Infant wide-field retinal image.
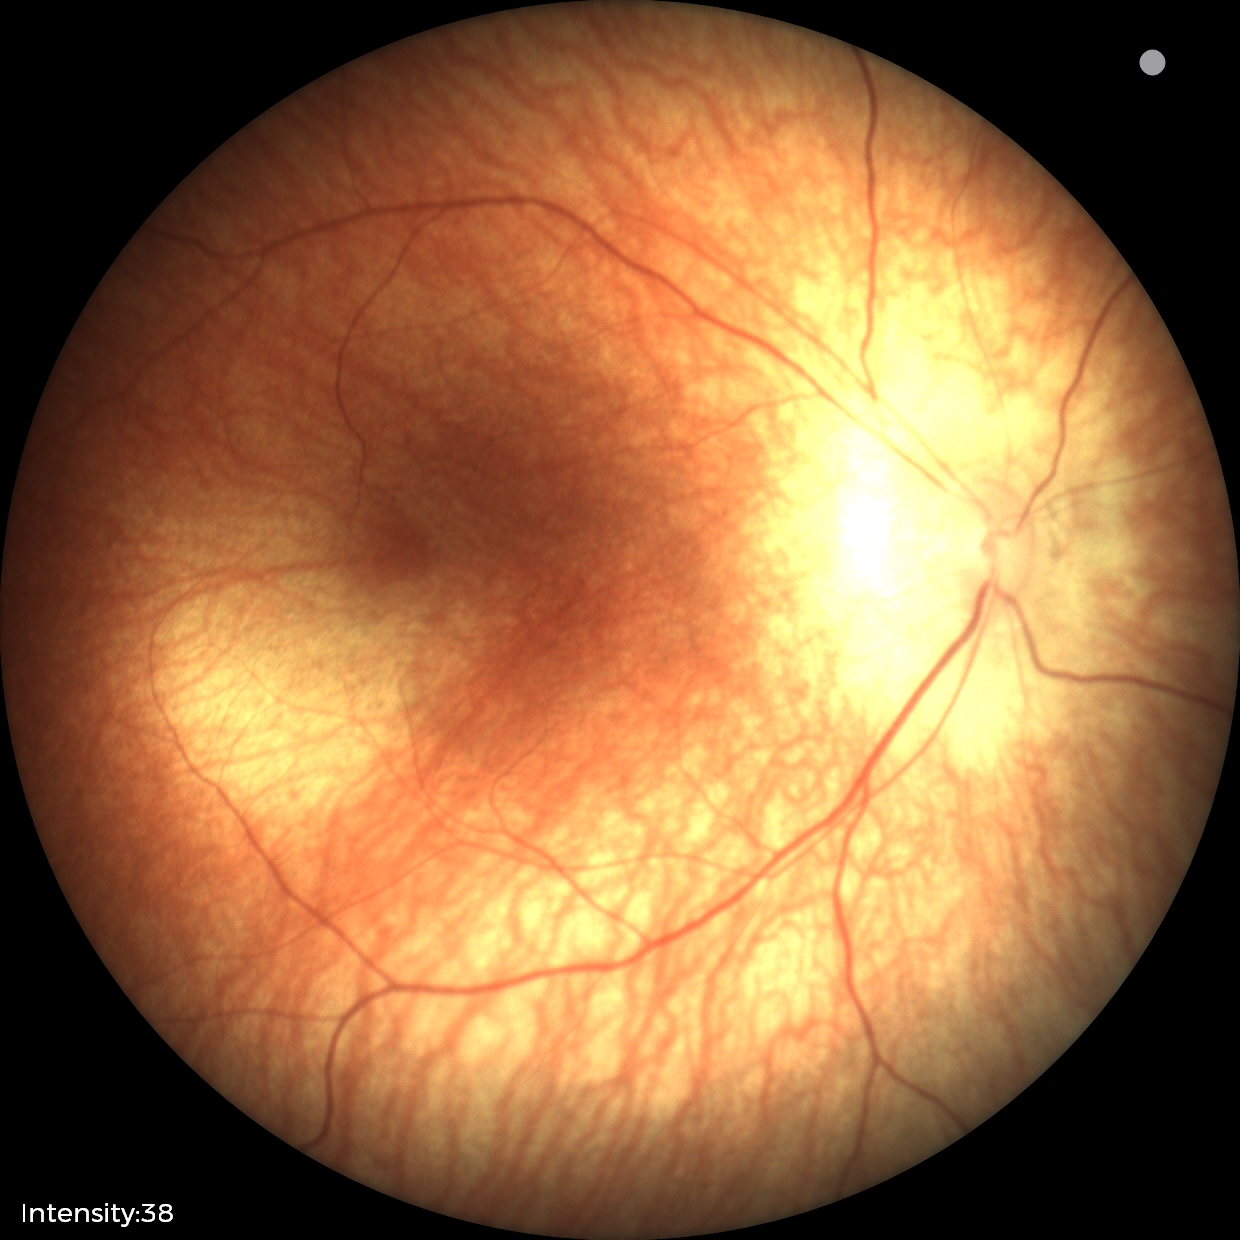

Screening diagnosis: no abnormal retinal findings.